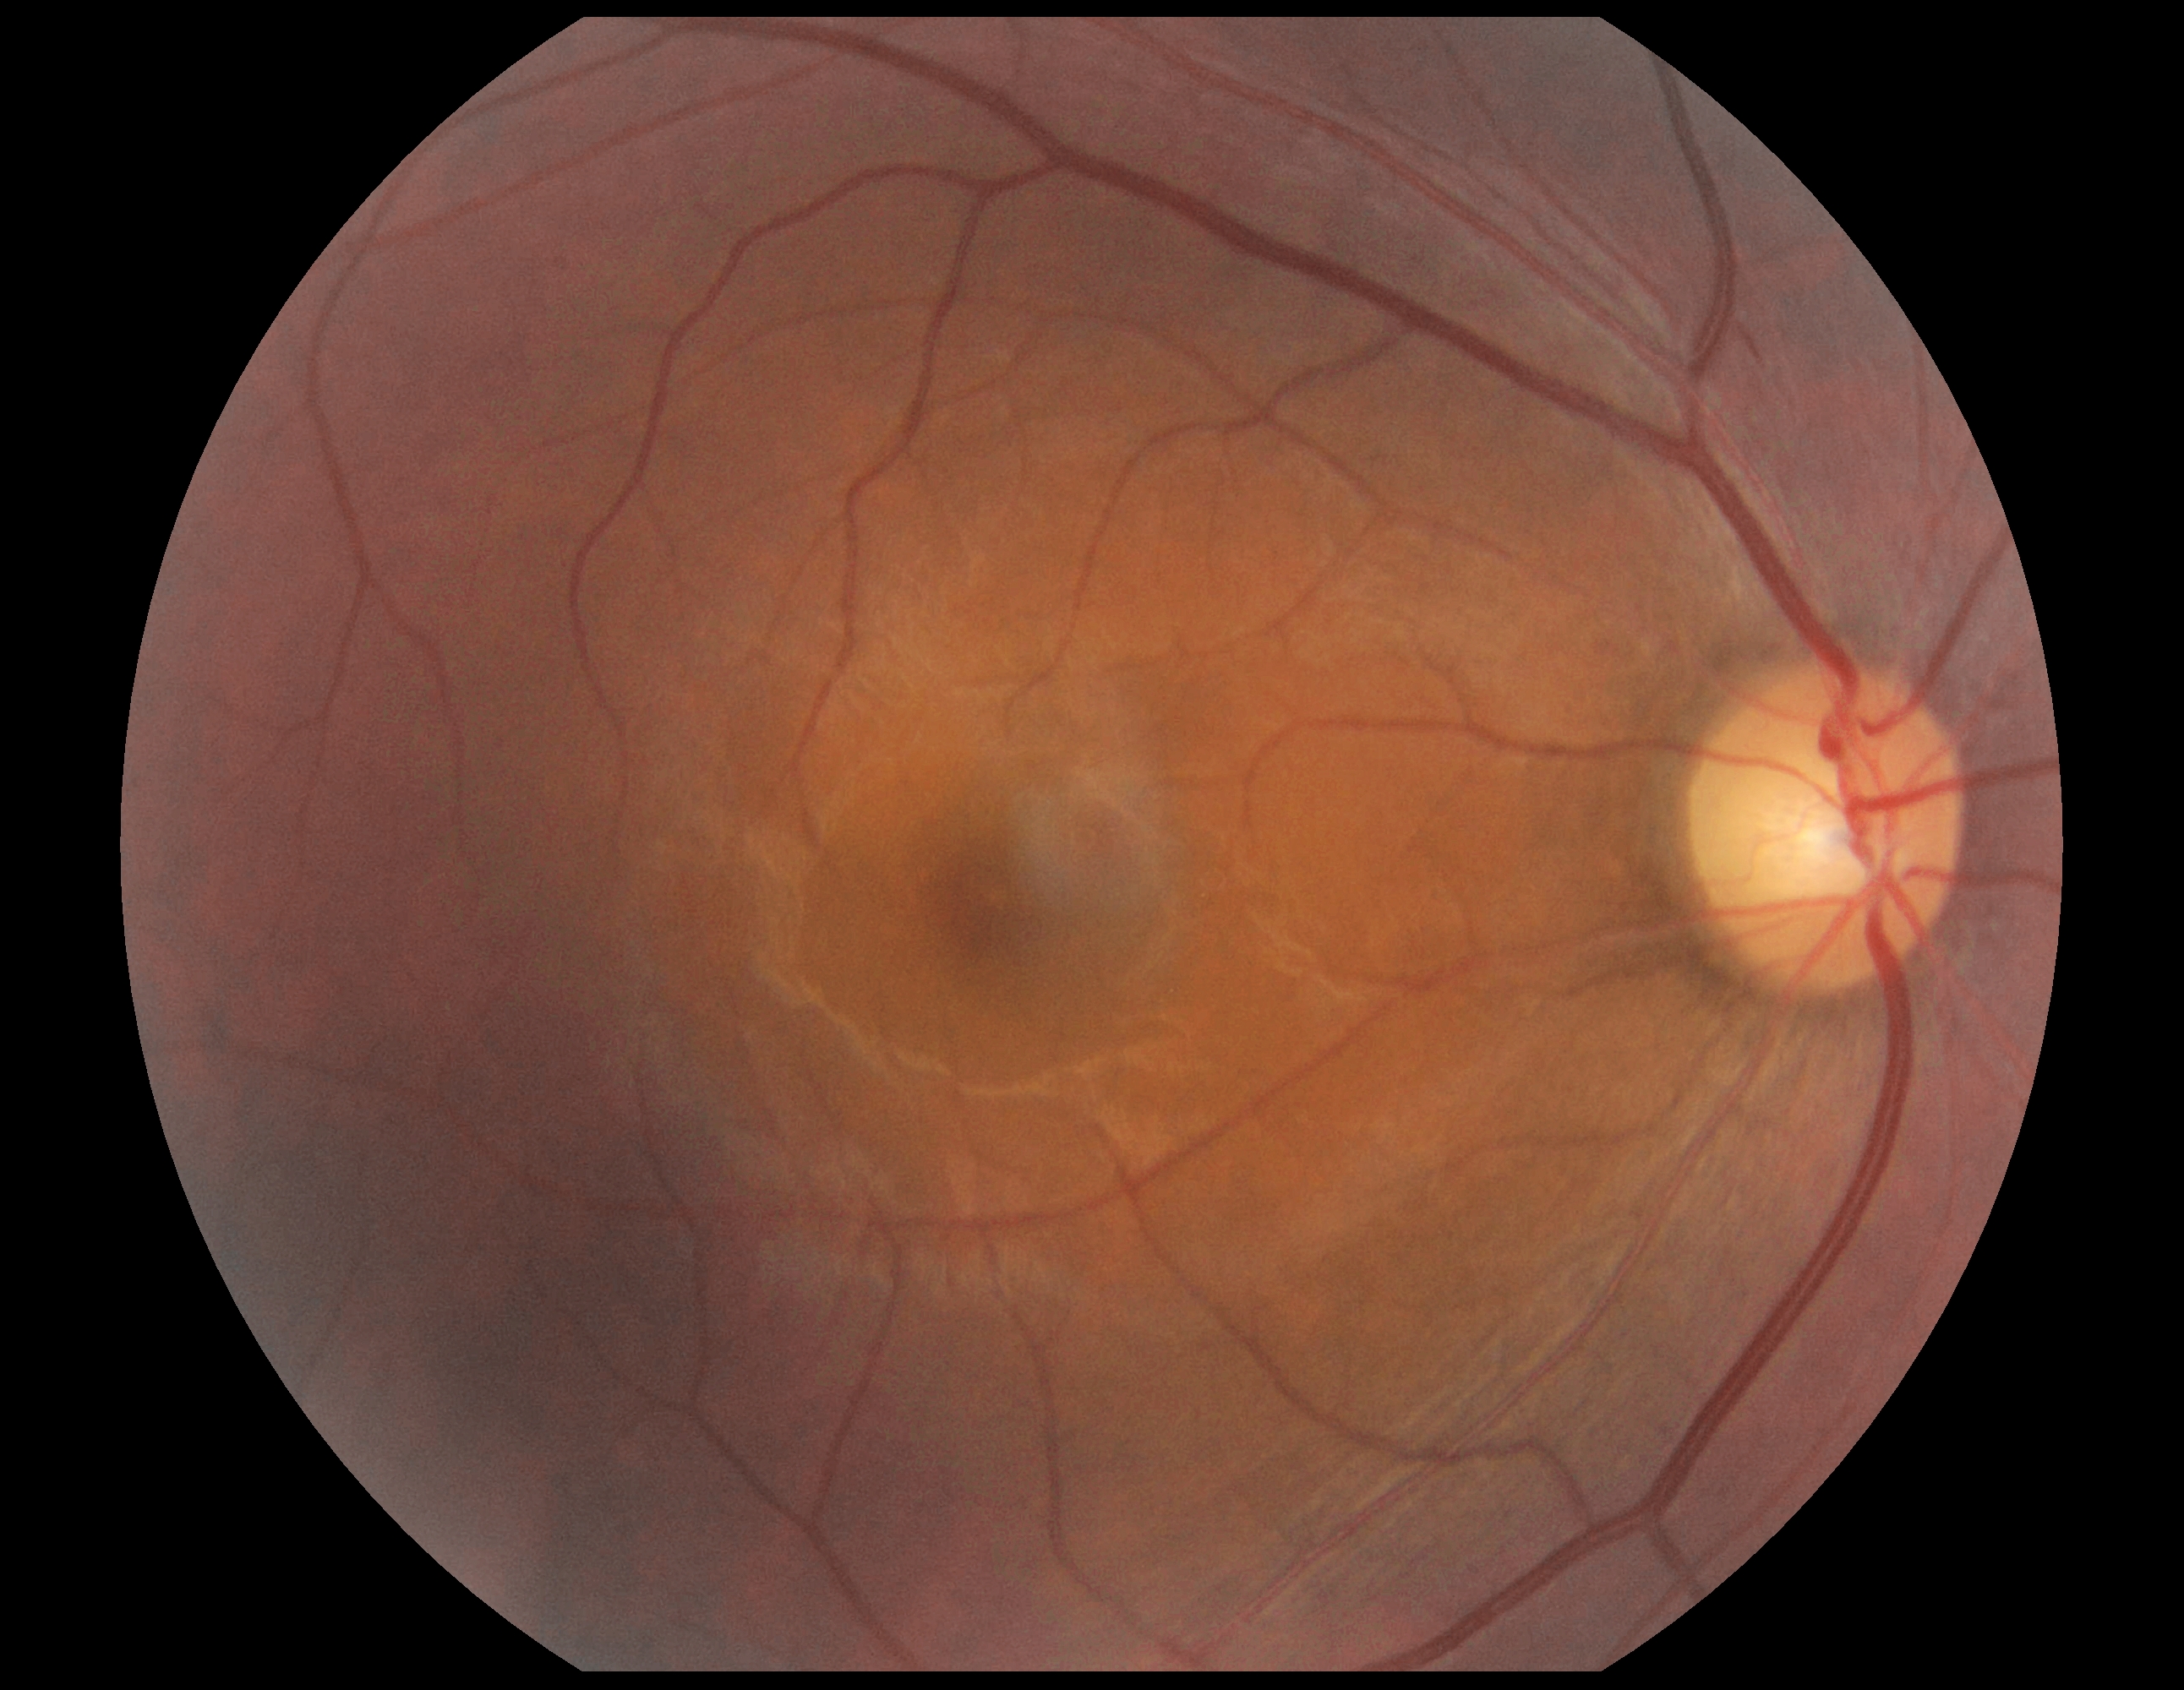 Diabetic retinopathy (DR): moderate non-proliferative diabetic retinopathy (grade 2).